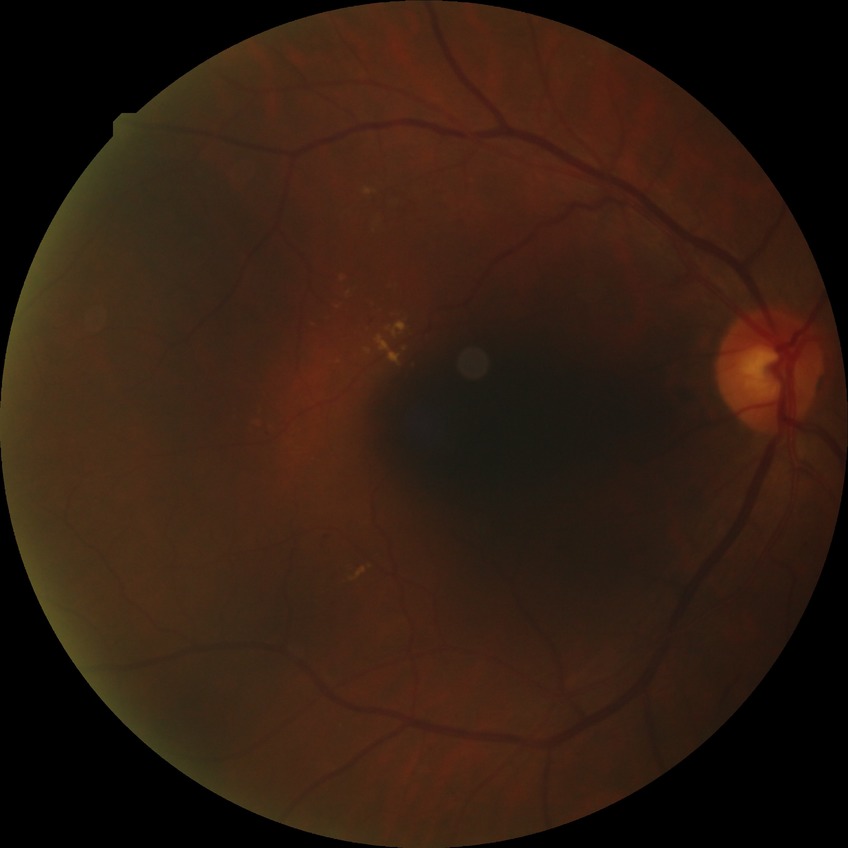 Disease class: non-proliferative diabetic retinopathy.
Diabetic retinopathy grade is simple diabetic retinopathy.